Centered on the optic disc; fundus photo.
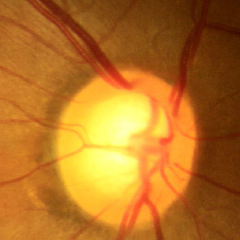

Glaucoma assessment = no glaucomatous optic neuropathy.